Retinal fundus photograph; image size 2212x1659
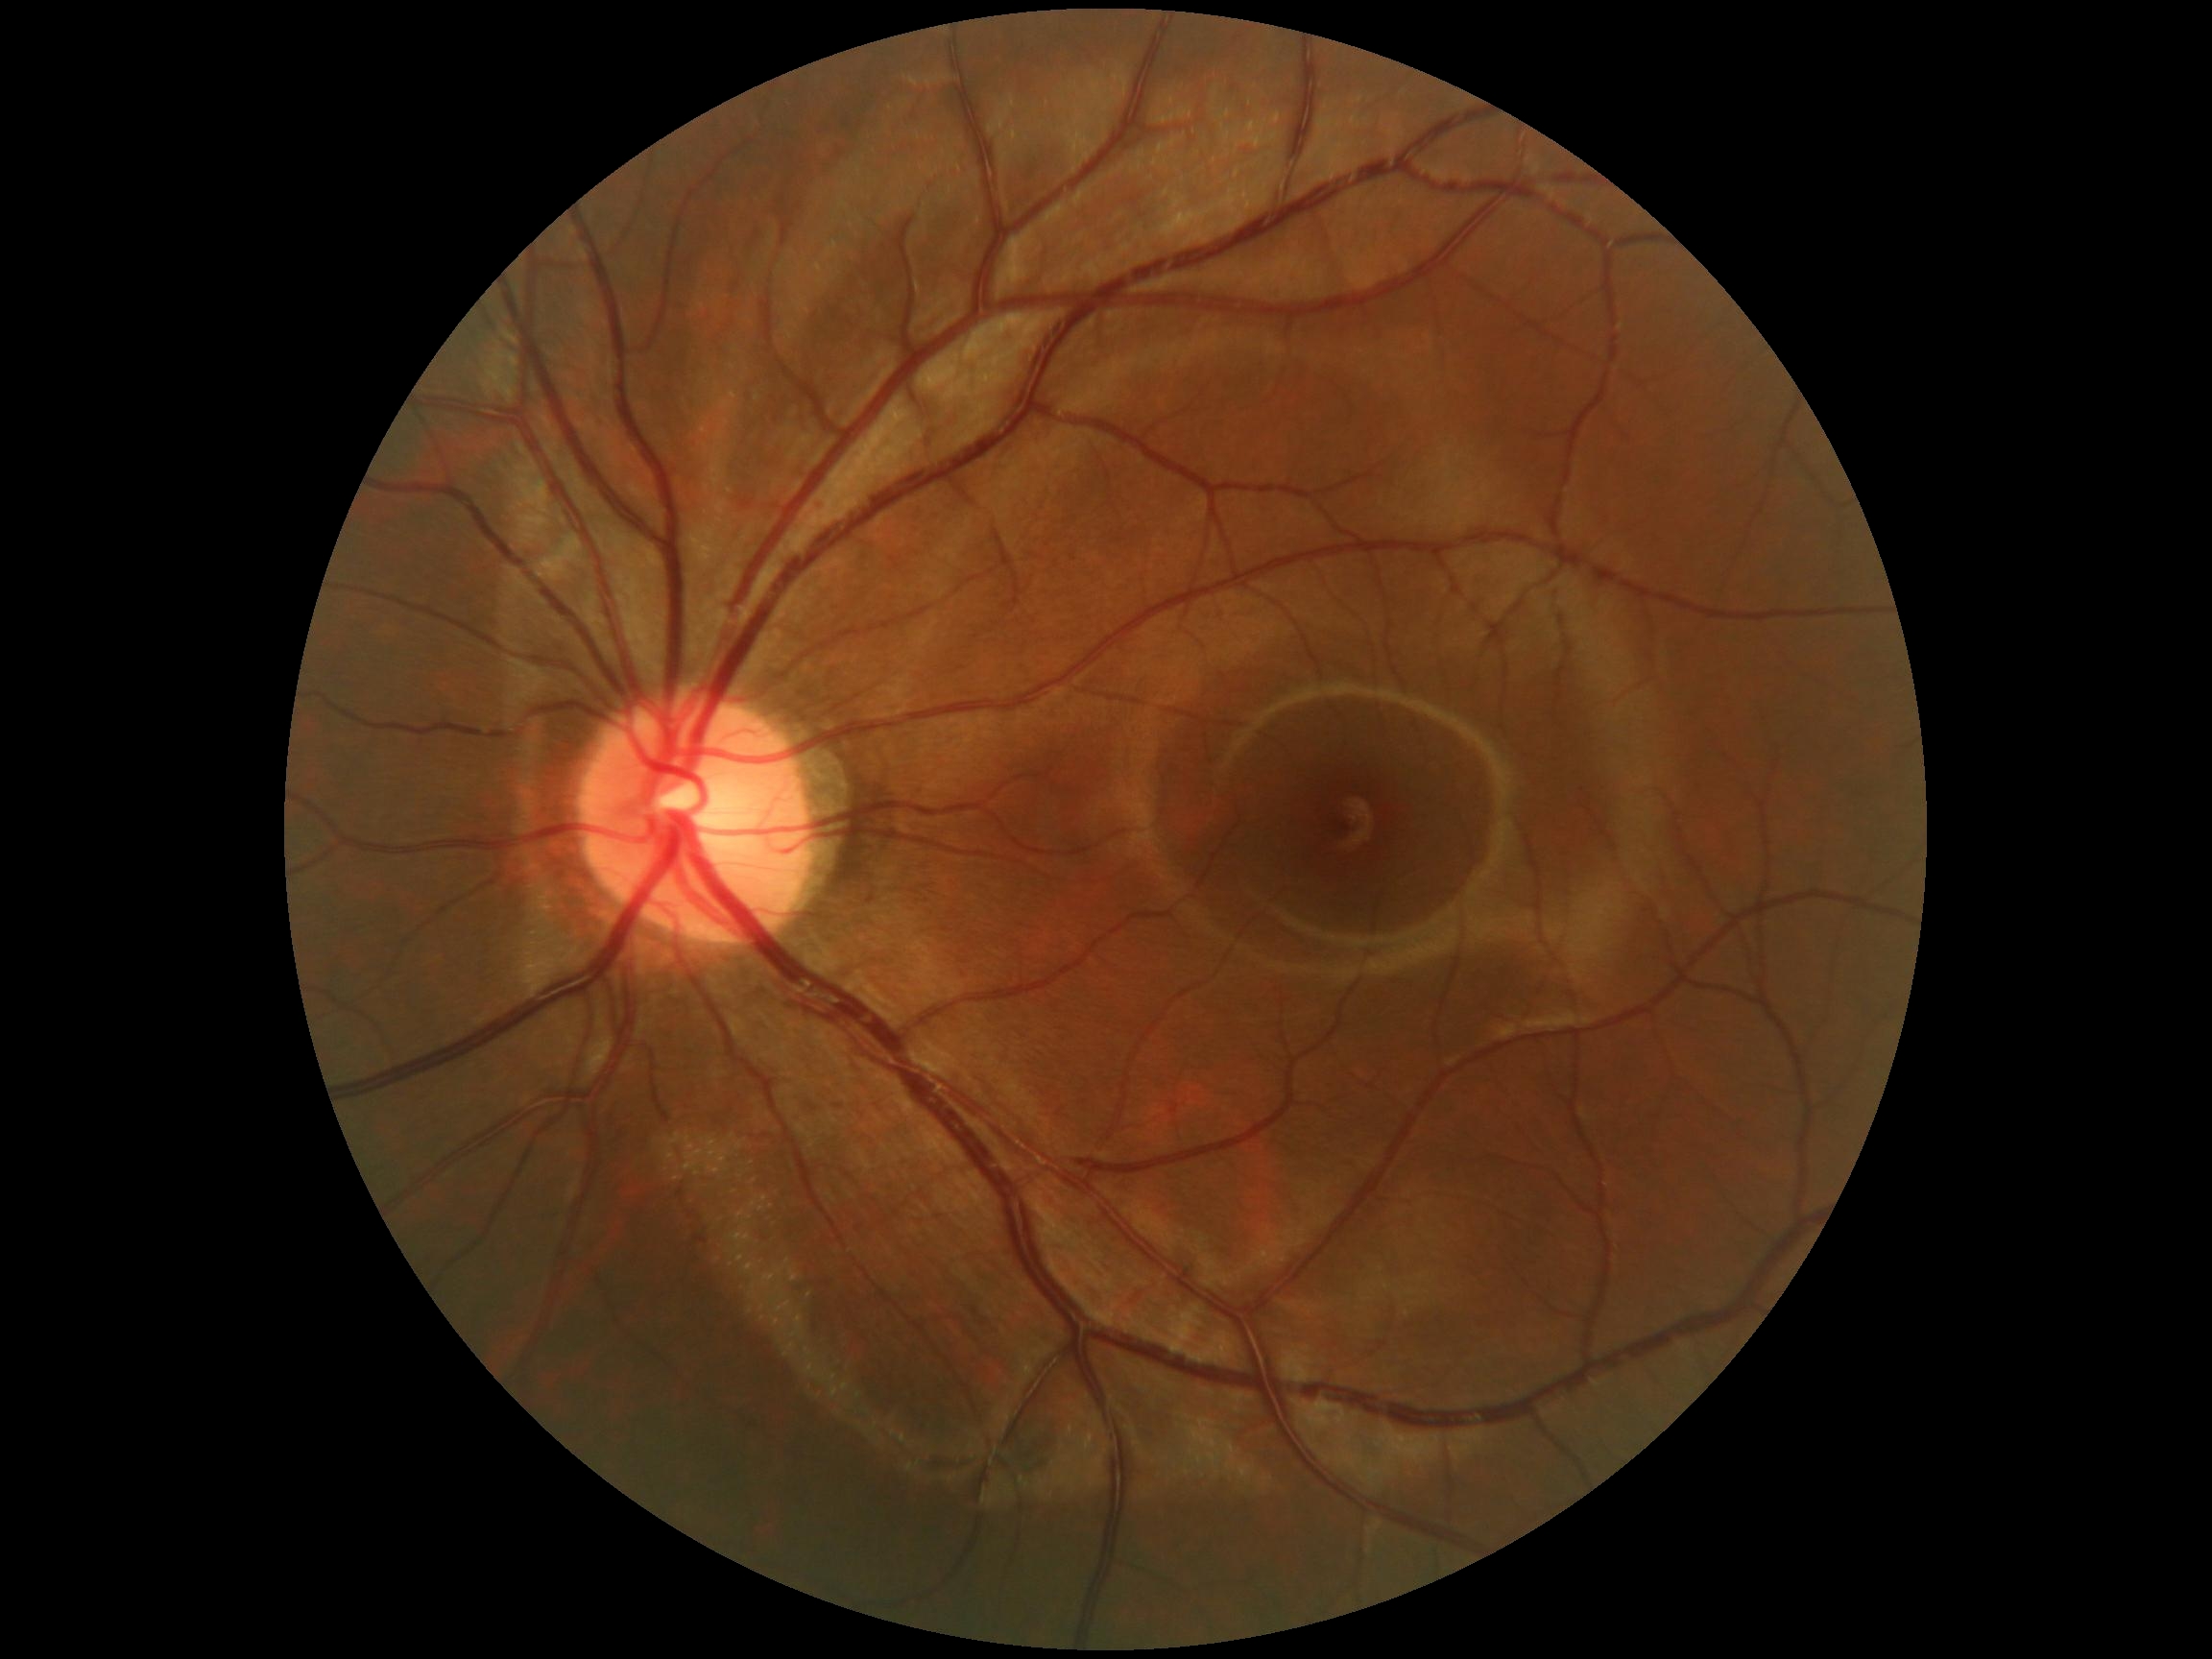

DR stage: grade 0 (no apparent retinopathy). No DR findings.